Pediatric retinal photograph (wide-field).
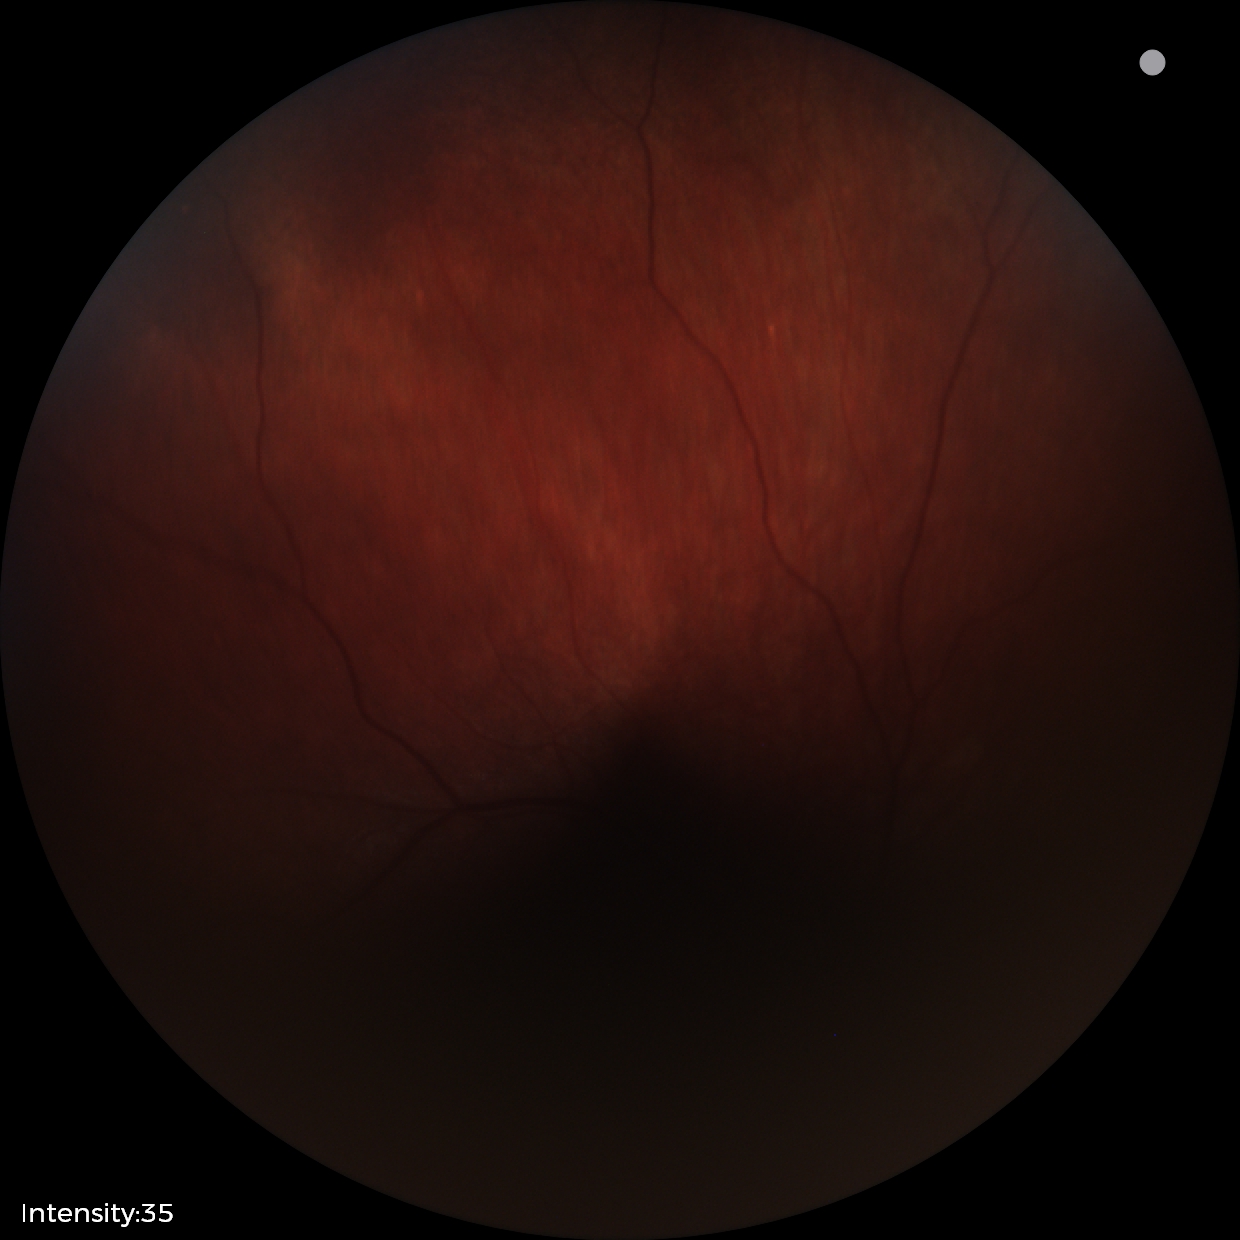
Screening examination consistent with retinal astrocytic hamartoma.